Retinal fundus photograph, 45-degree field of view
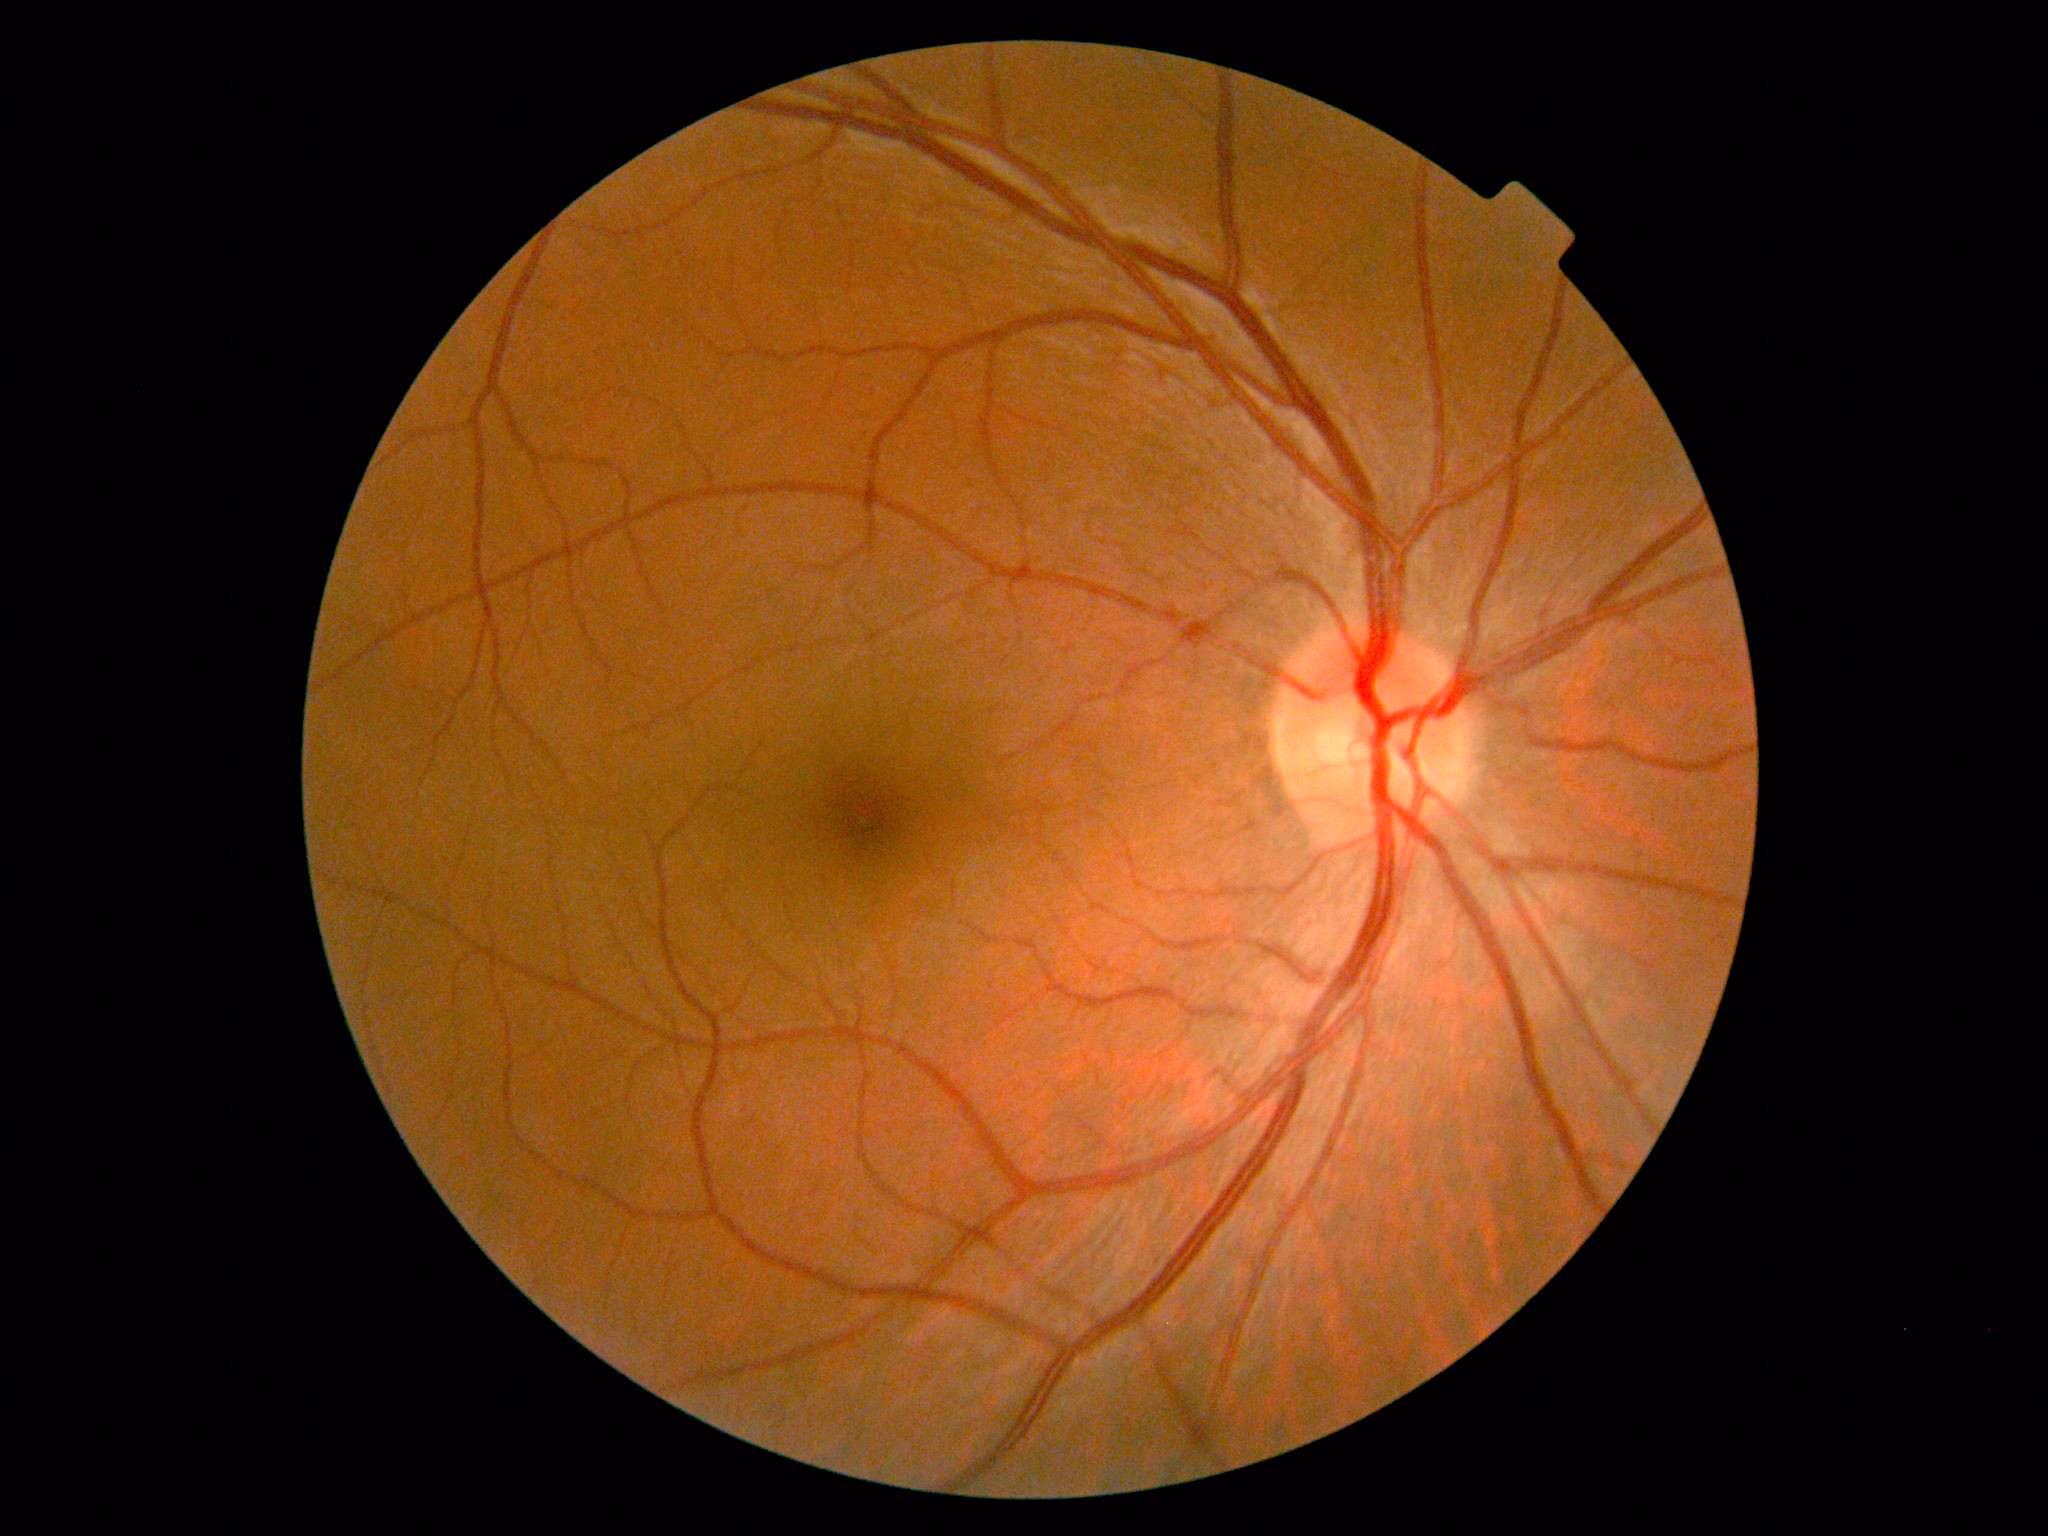
DR severity: grade 0; DR impression: no apparent DR.